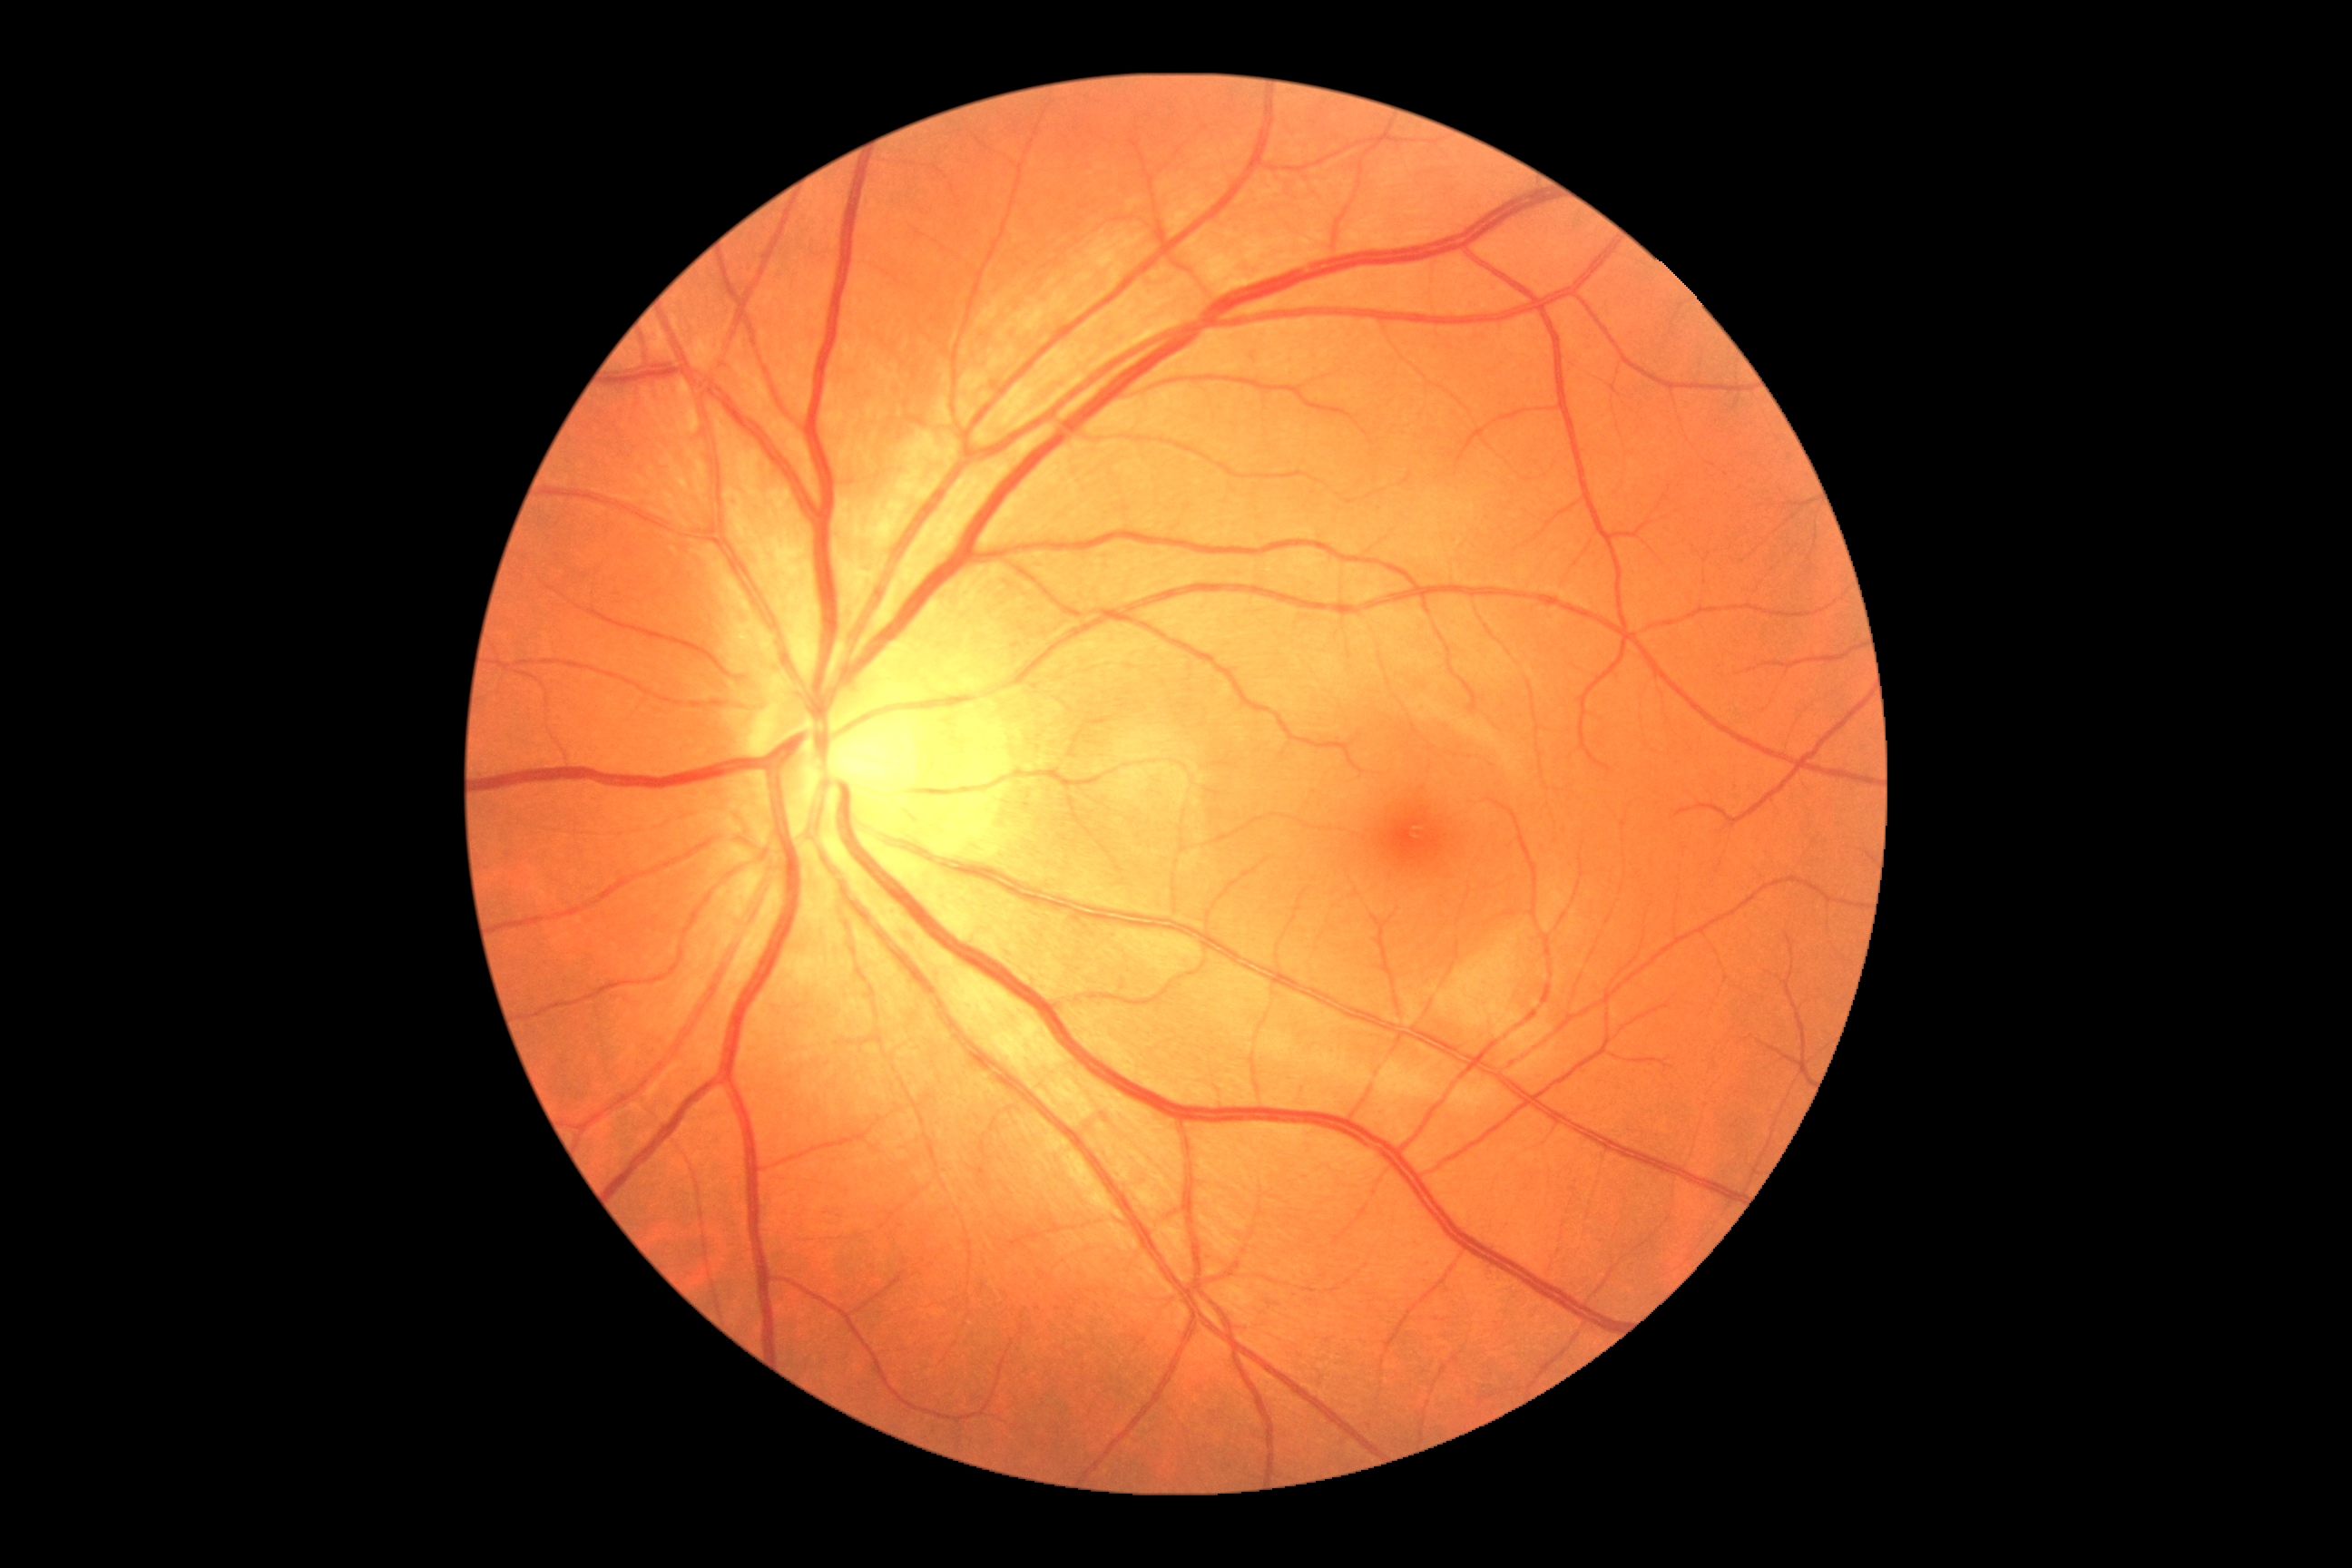 dr_grade: no apparent diabetic retinopathy (0) — no visible signs of diabetic retinopathy